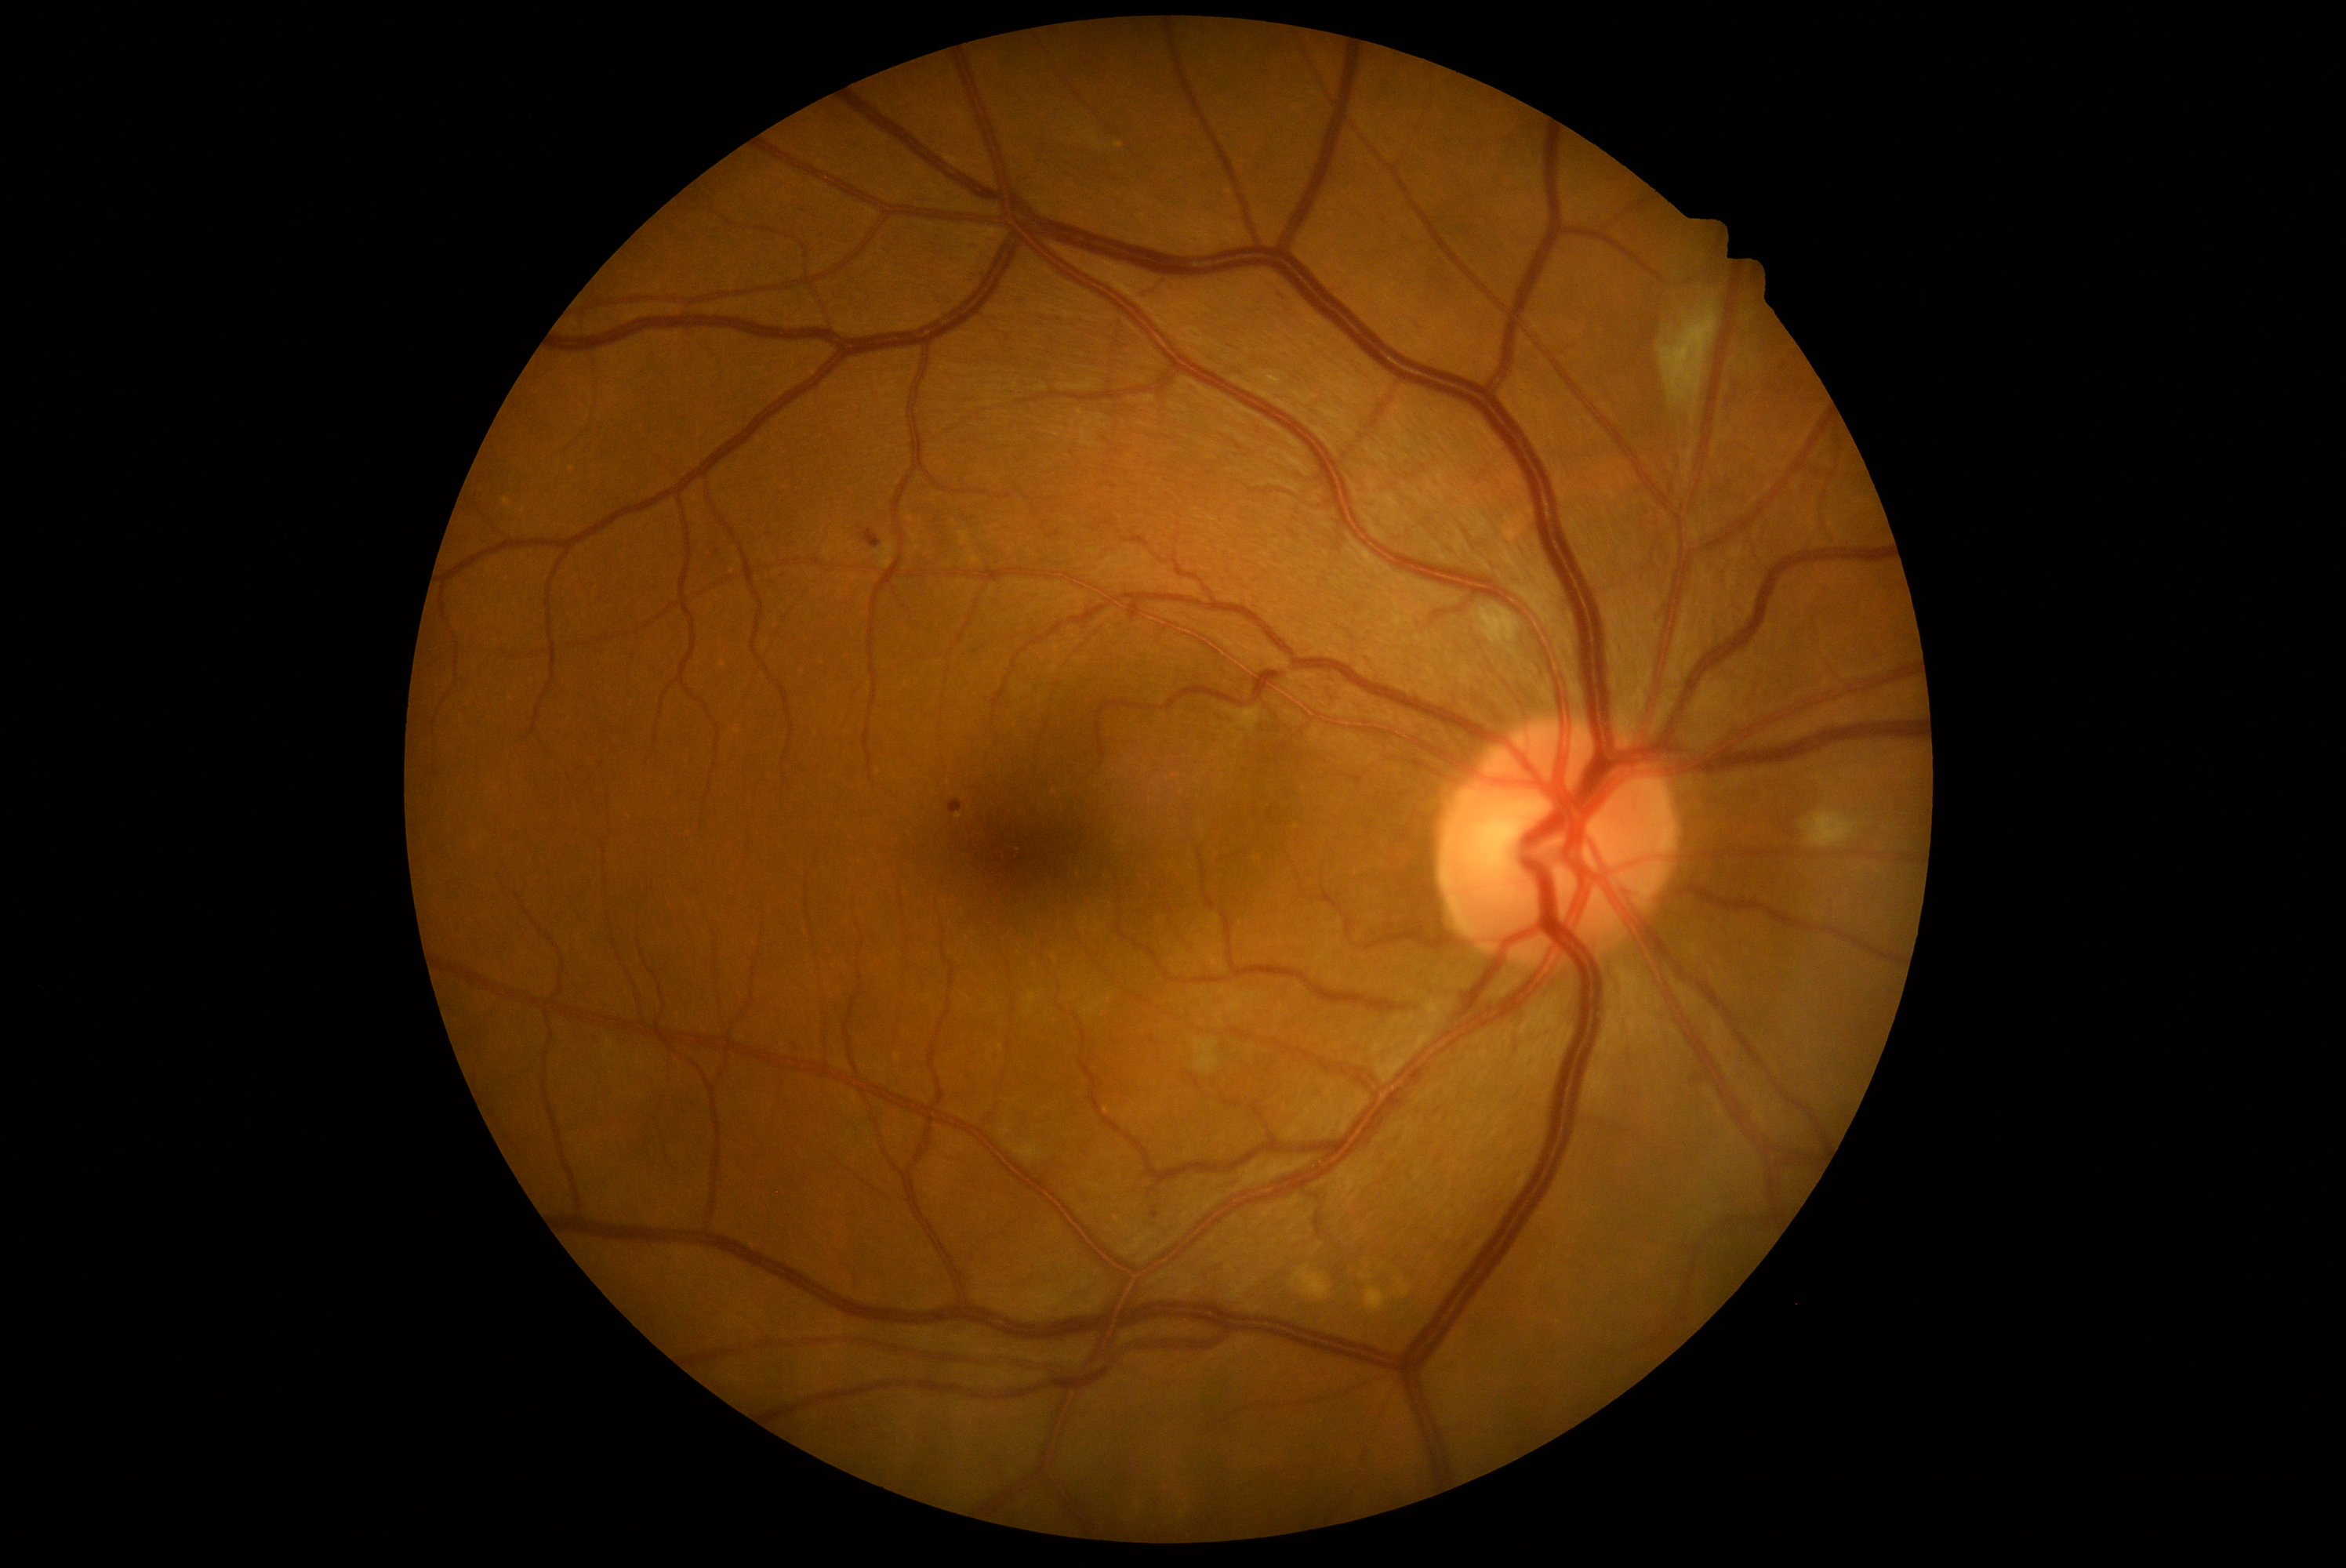
– diabetic retinopathy (DR) — 2/4 — more than just microaneurysms but less than severe NPDR